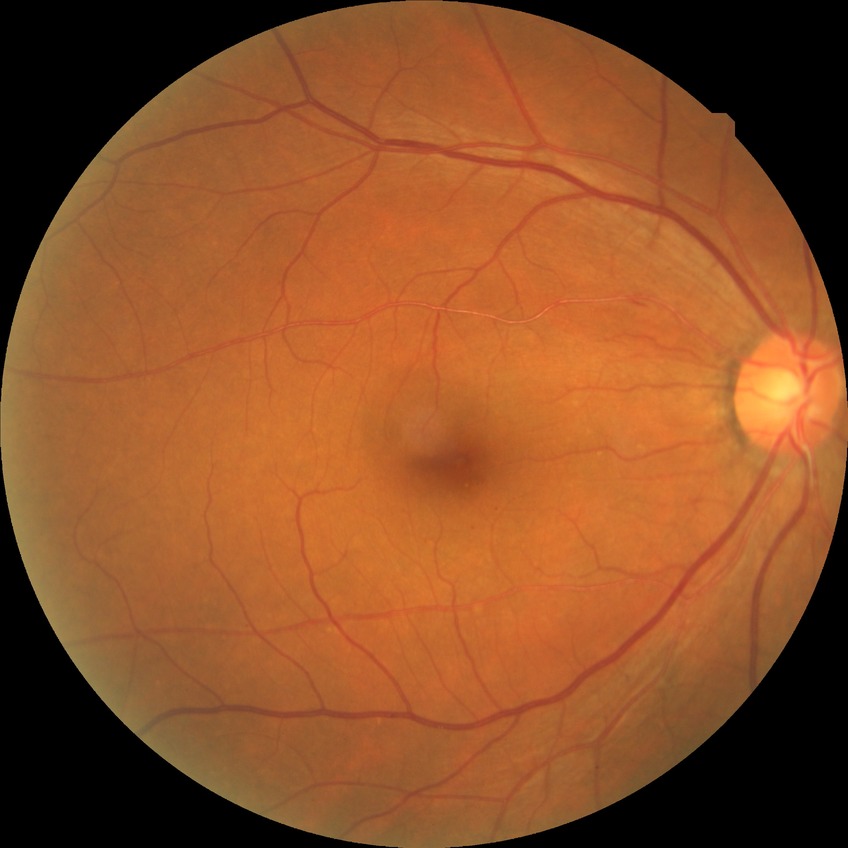

Diabetic retinopathy (DR) is SDR (simple diabetic retinopathy).